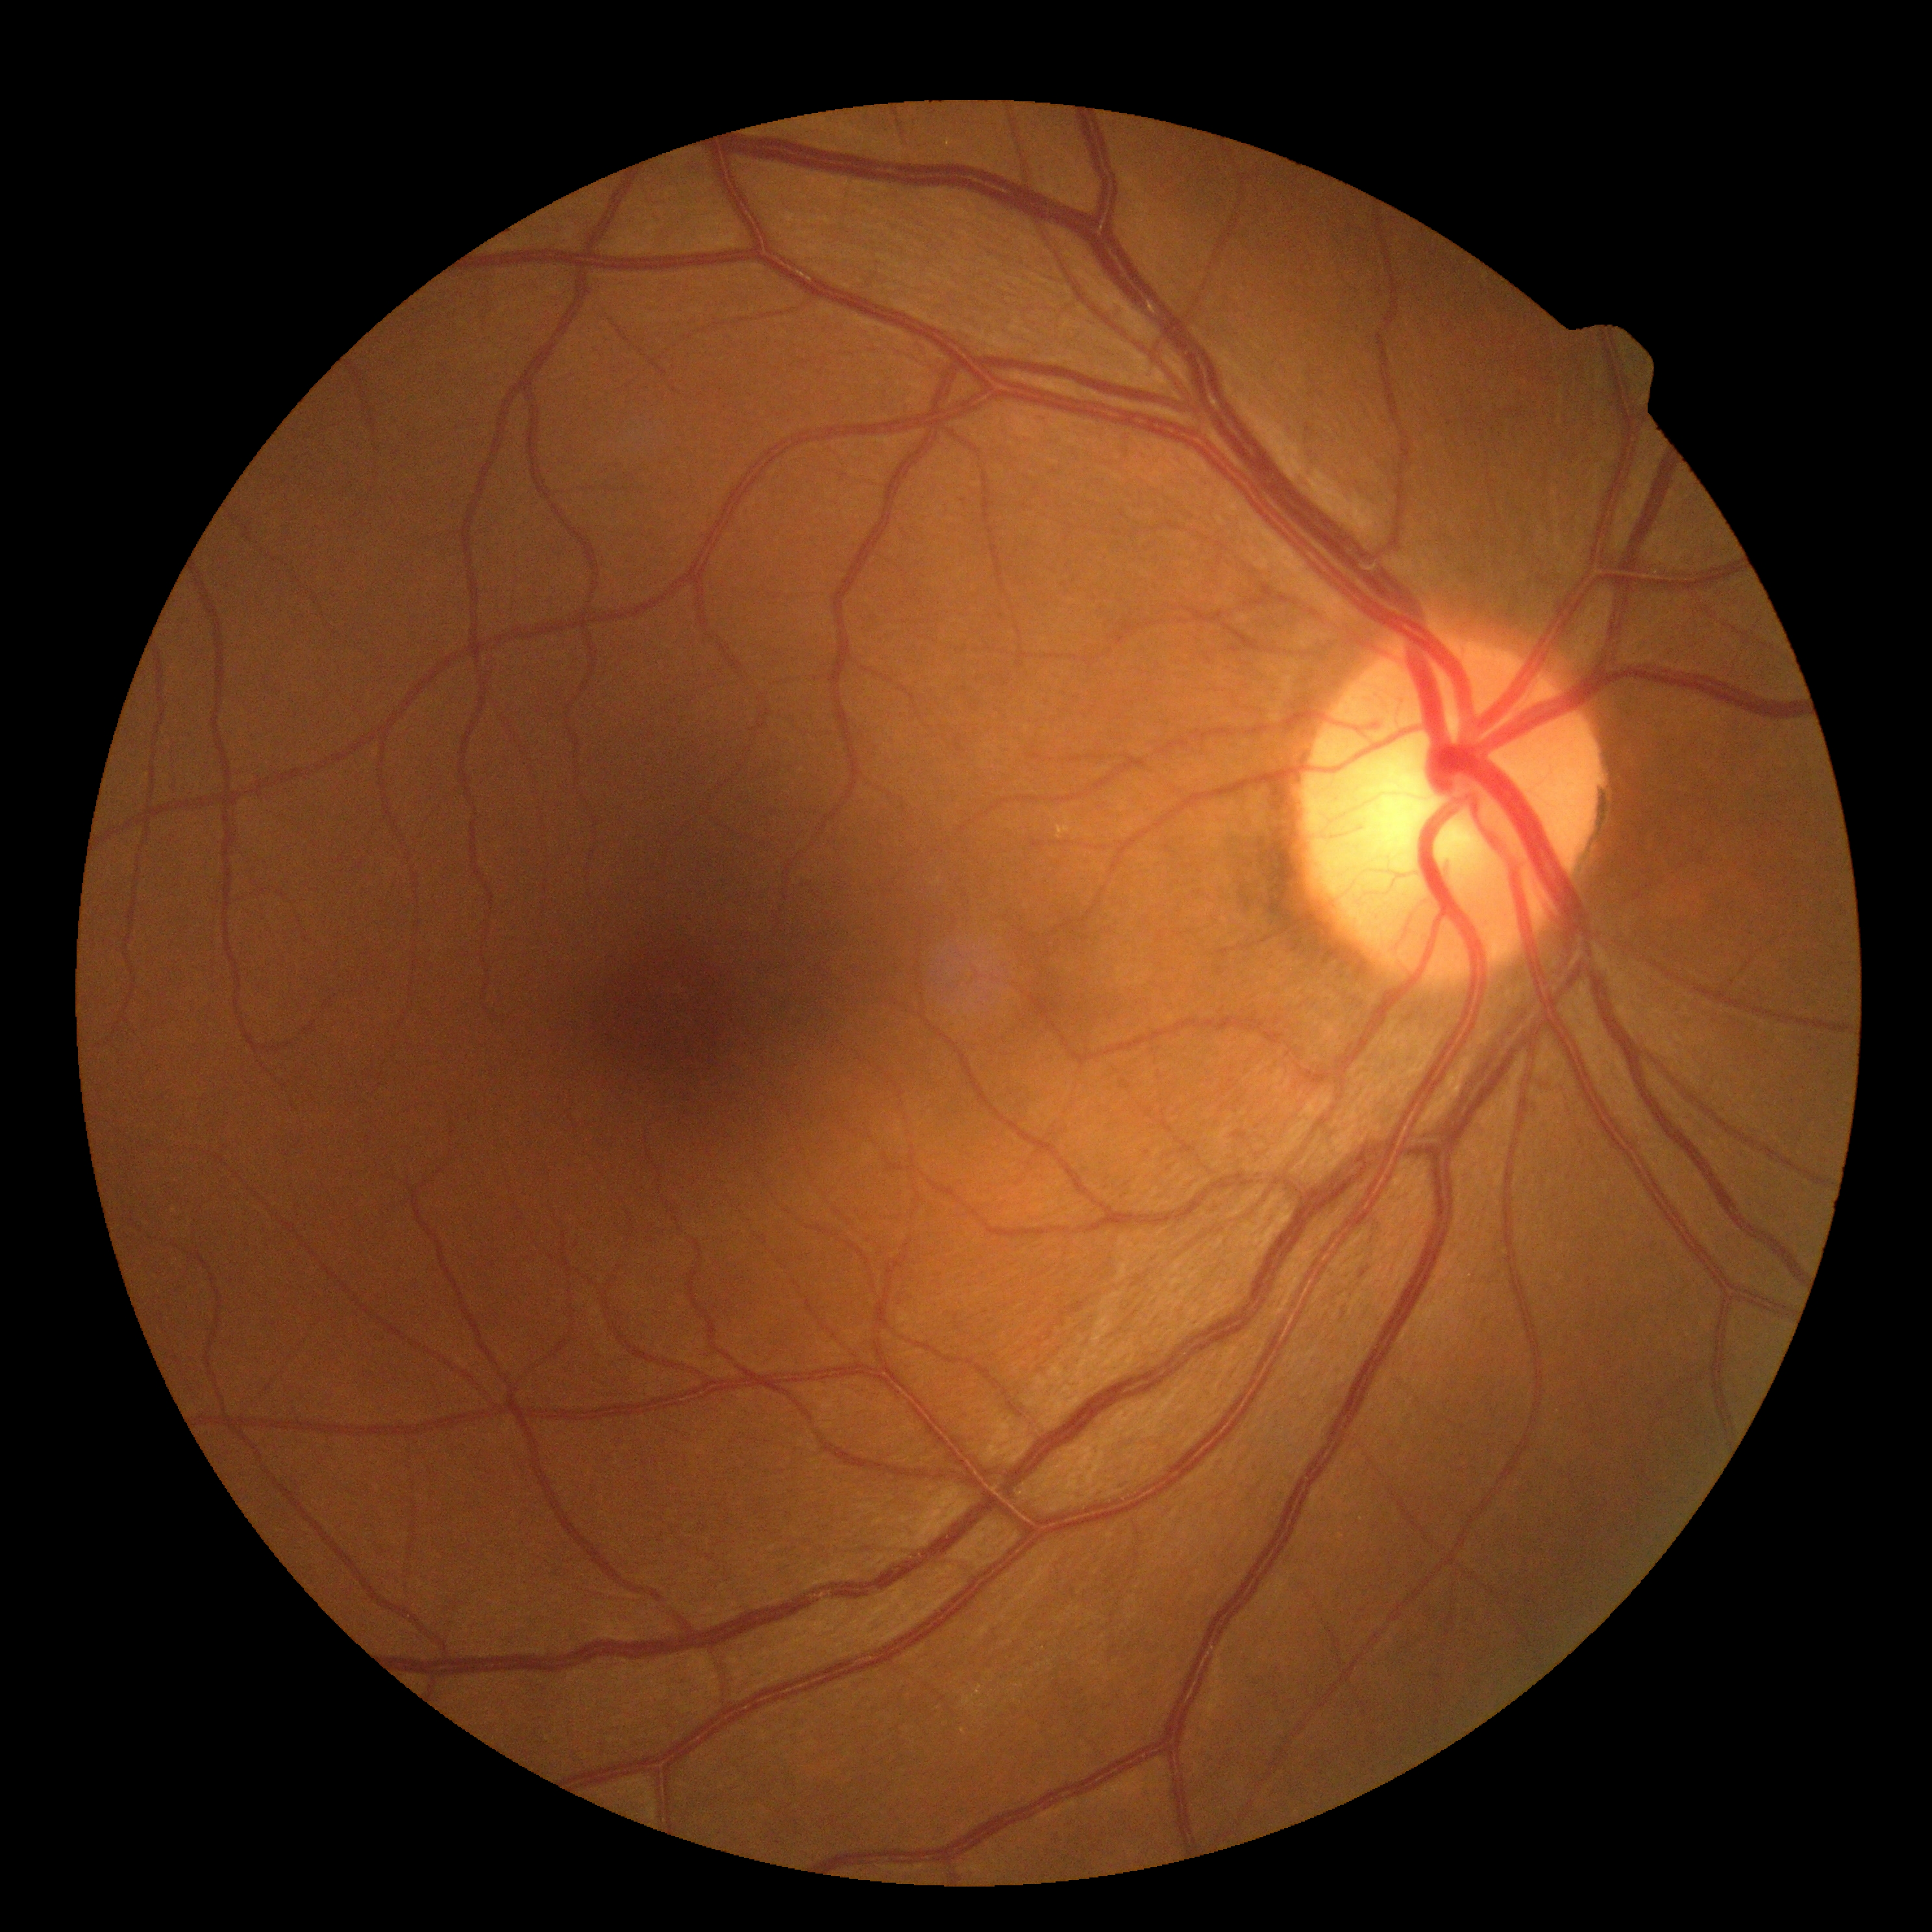

retinopathy grade=0; DR impression=no DR findings.